Modified Davis classification.
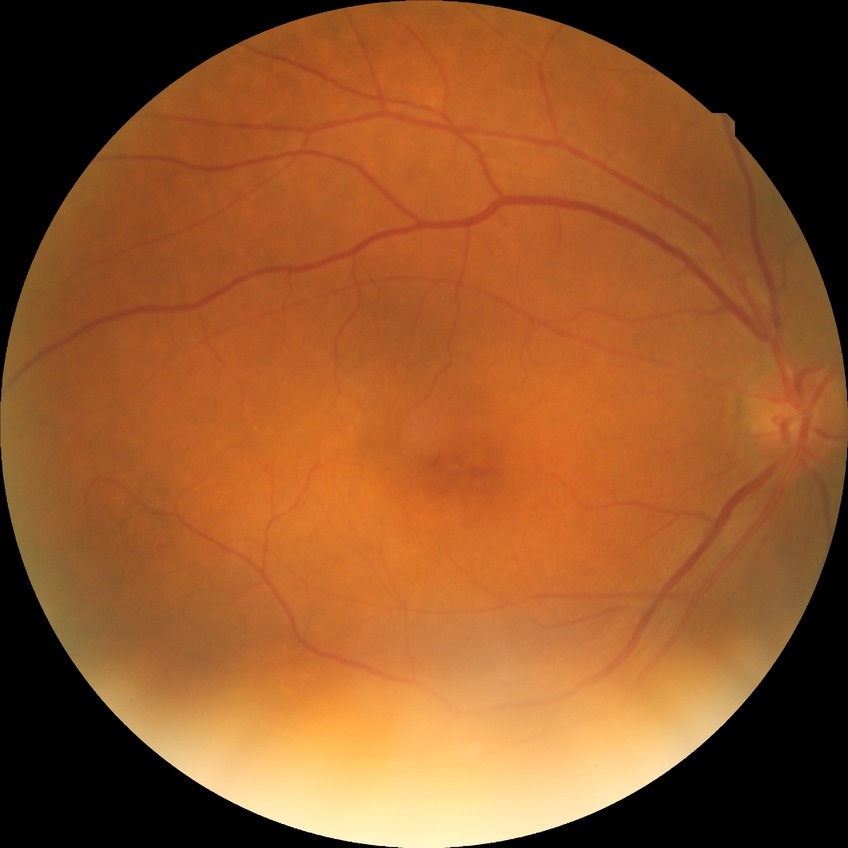

davis_grade: simple diabetic retinopathy (SDR)